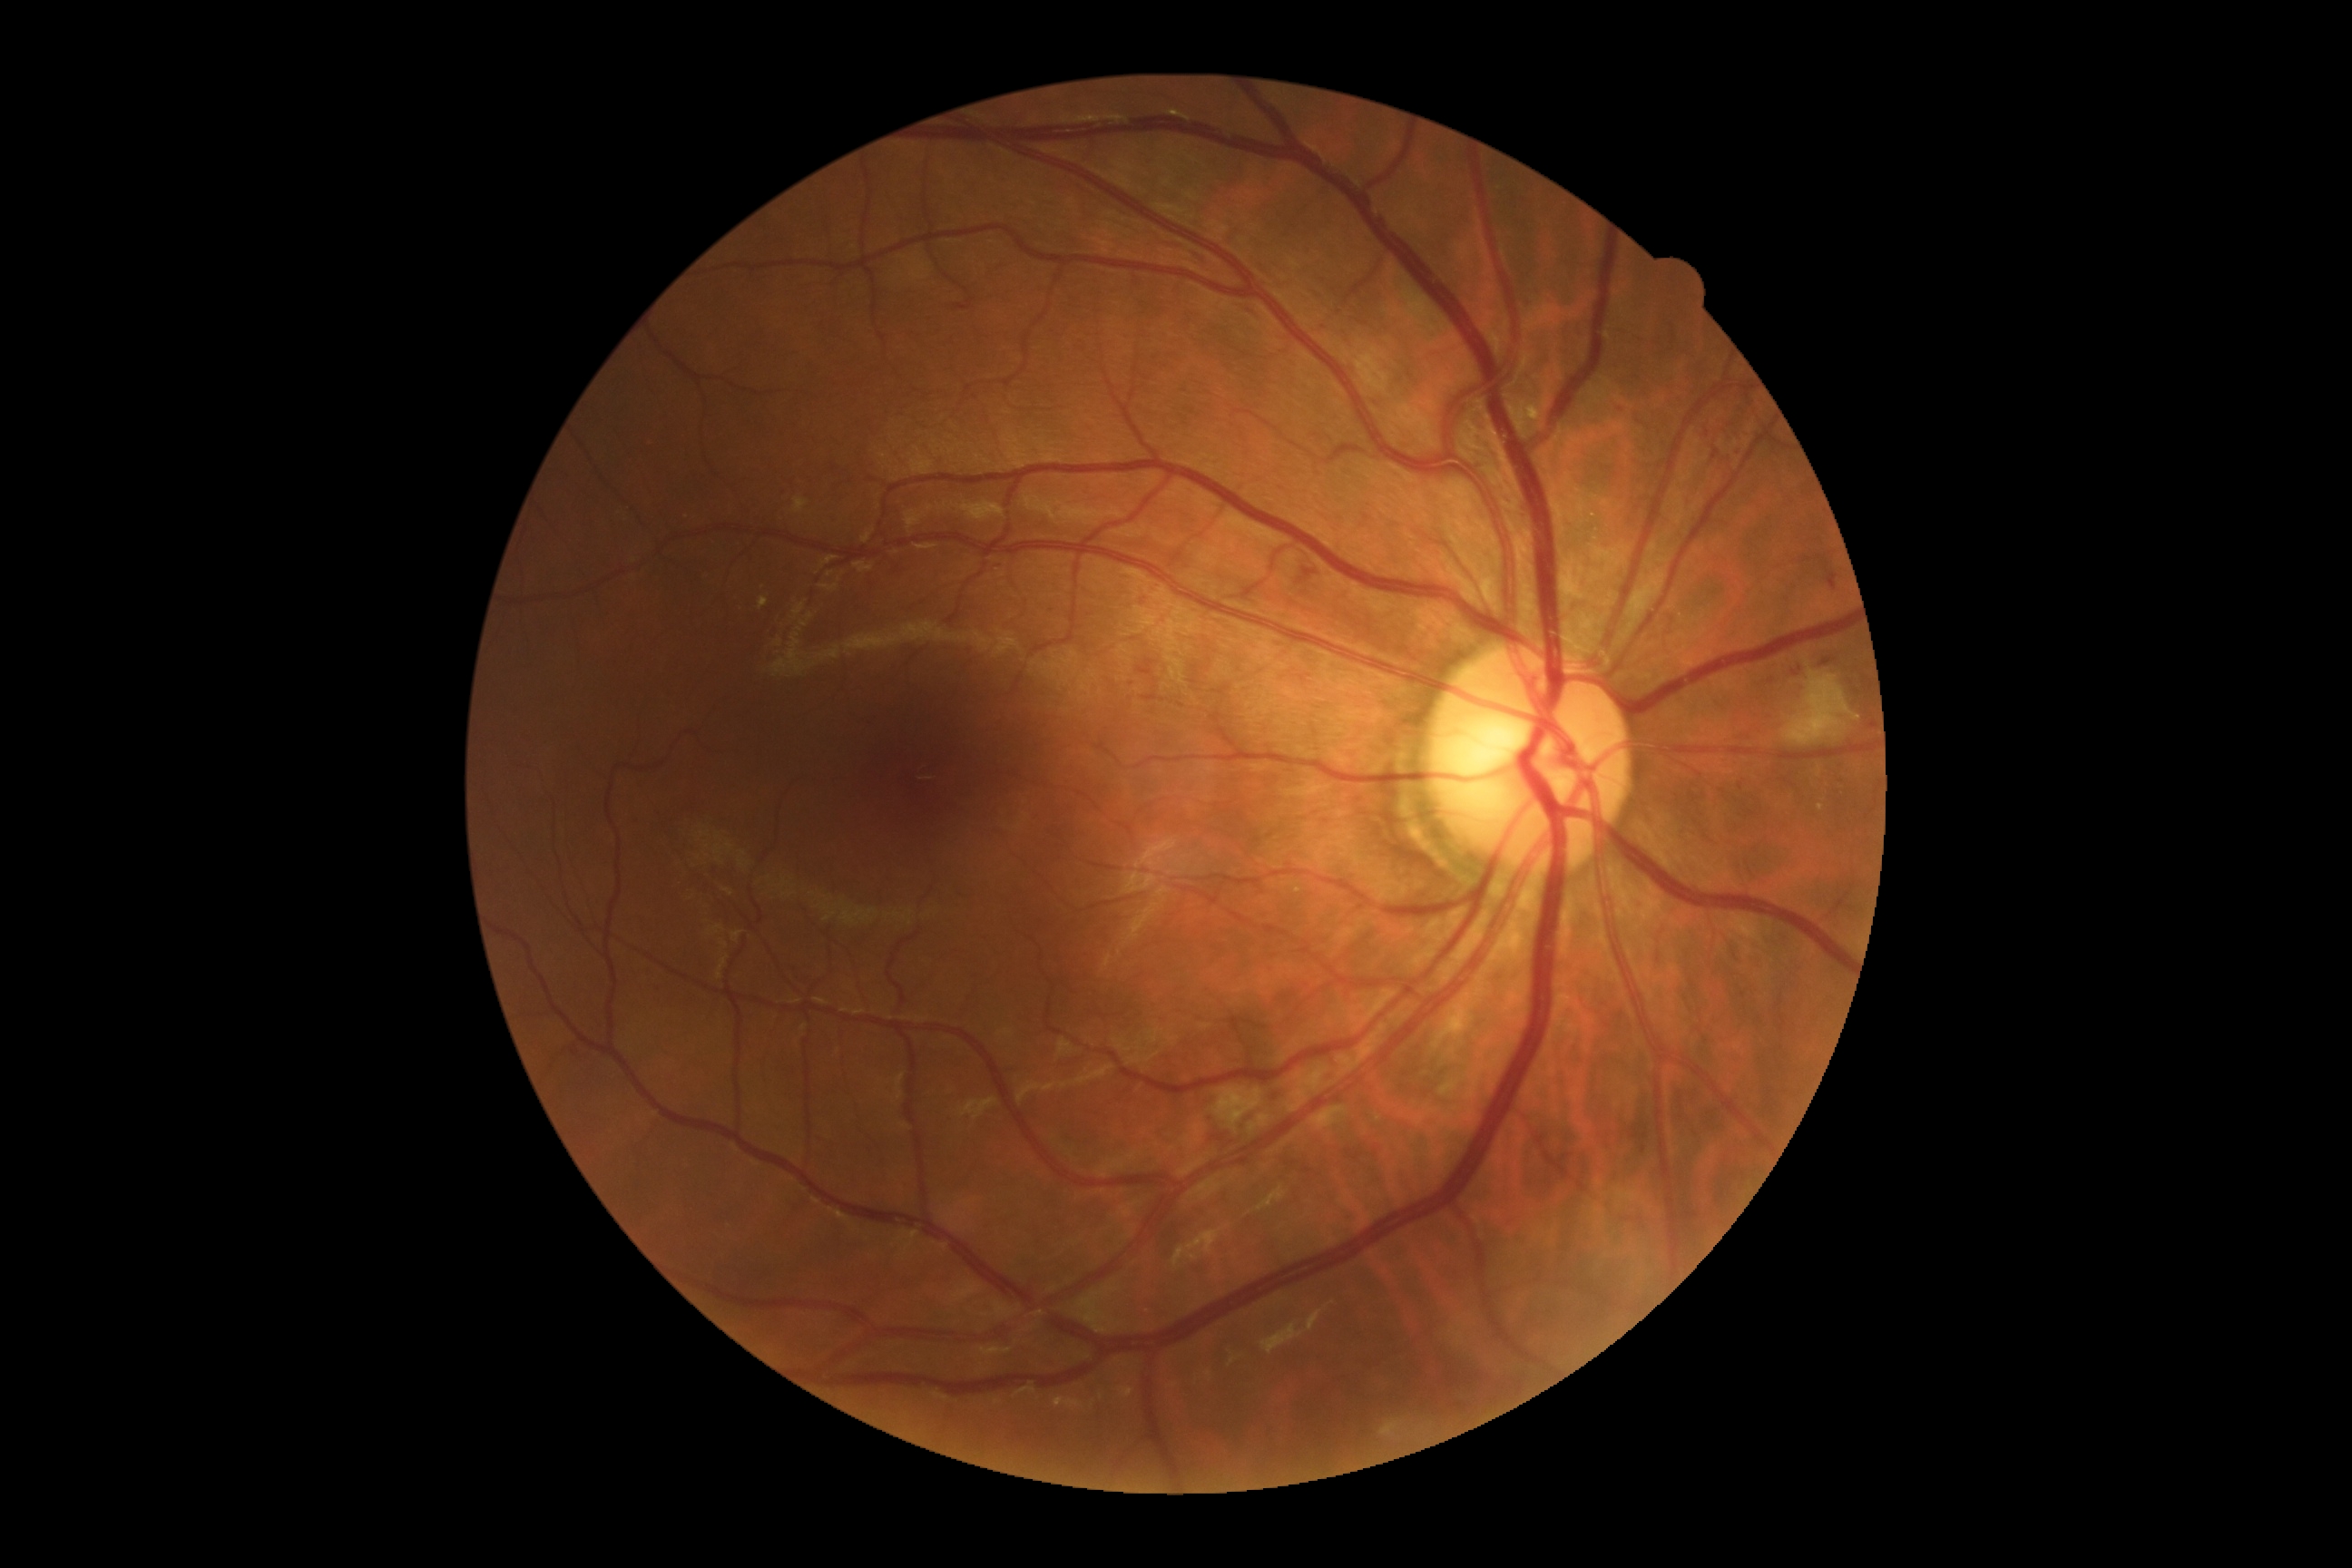 Annotations:
– diabetic retinopathy — 2/4